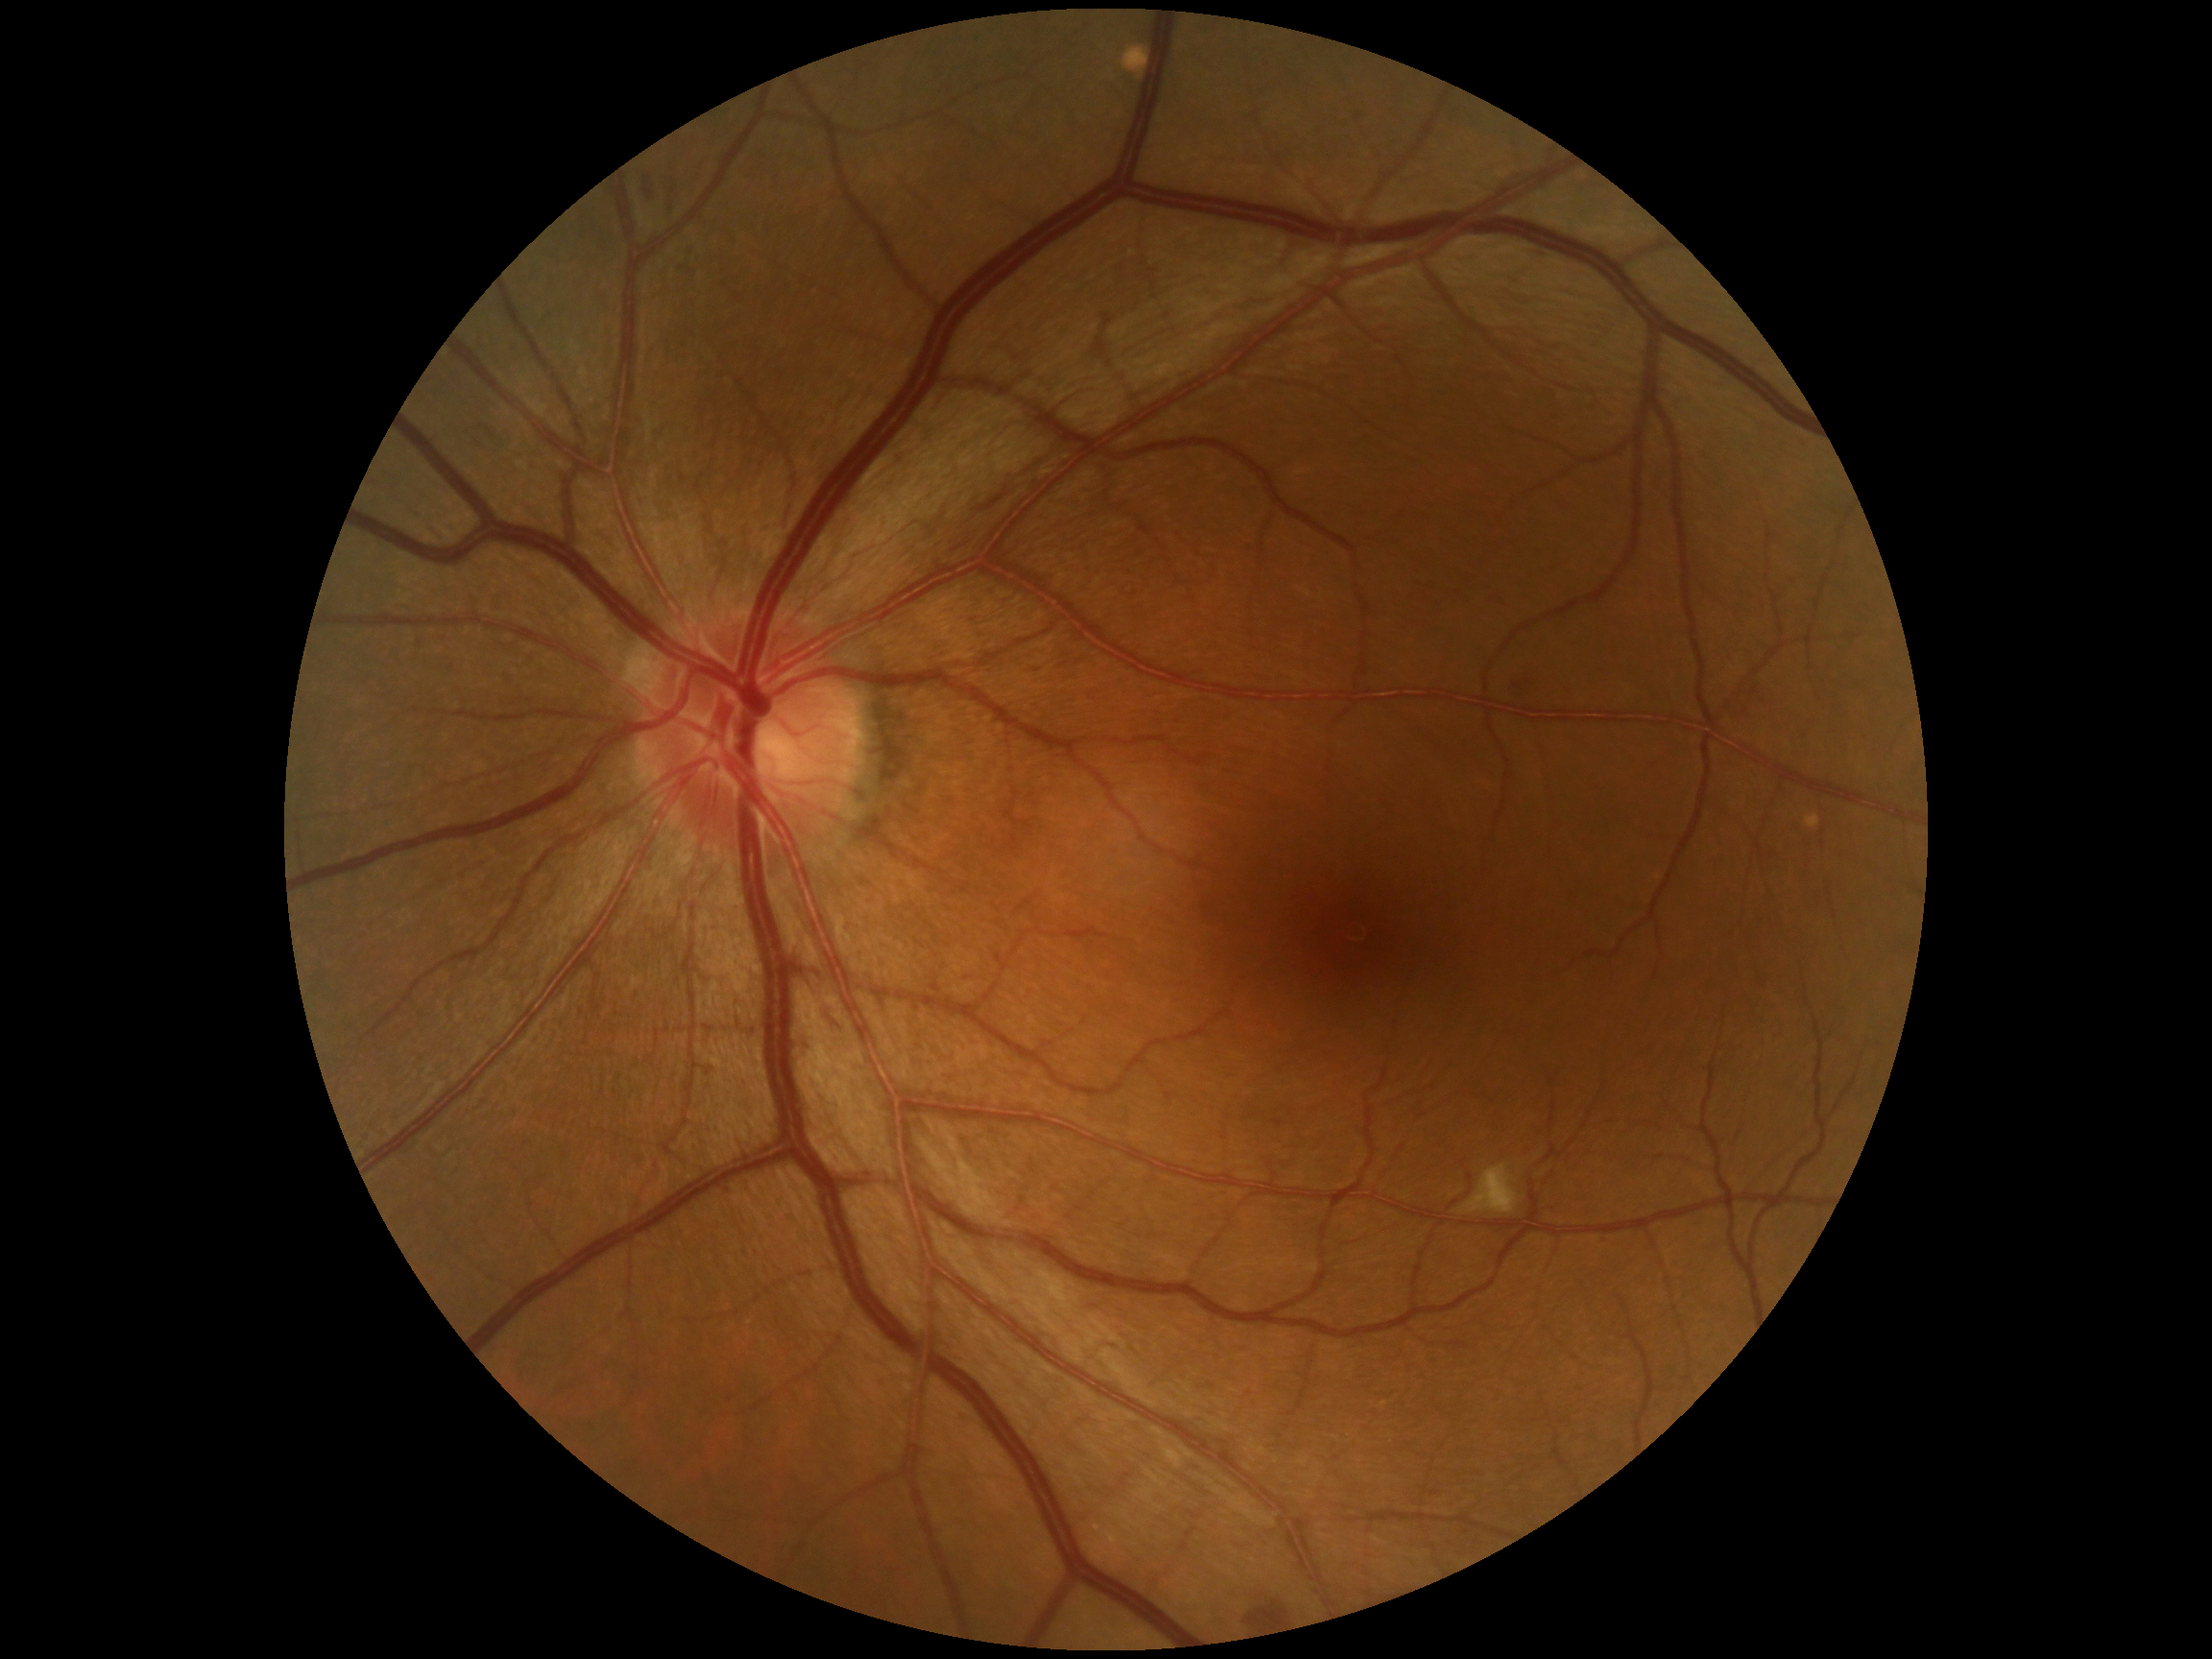

Diabetic retinopathy grade: 2 (moderate NPDR).